CFP · 2212 x 1659 pixels
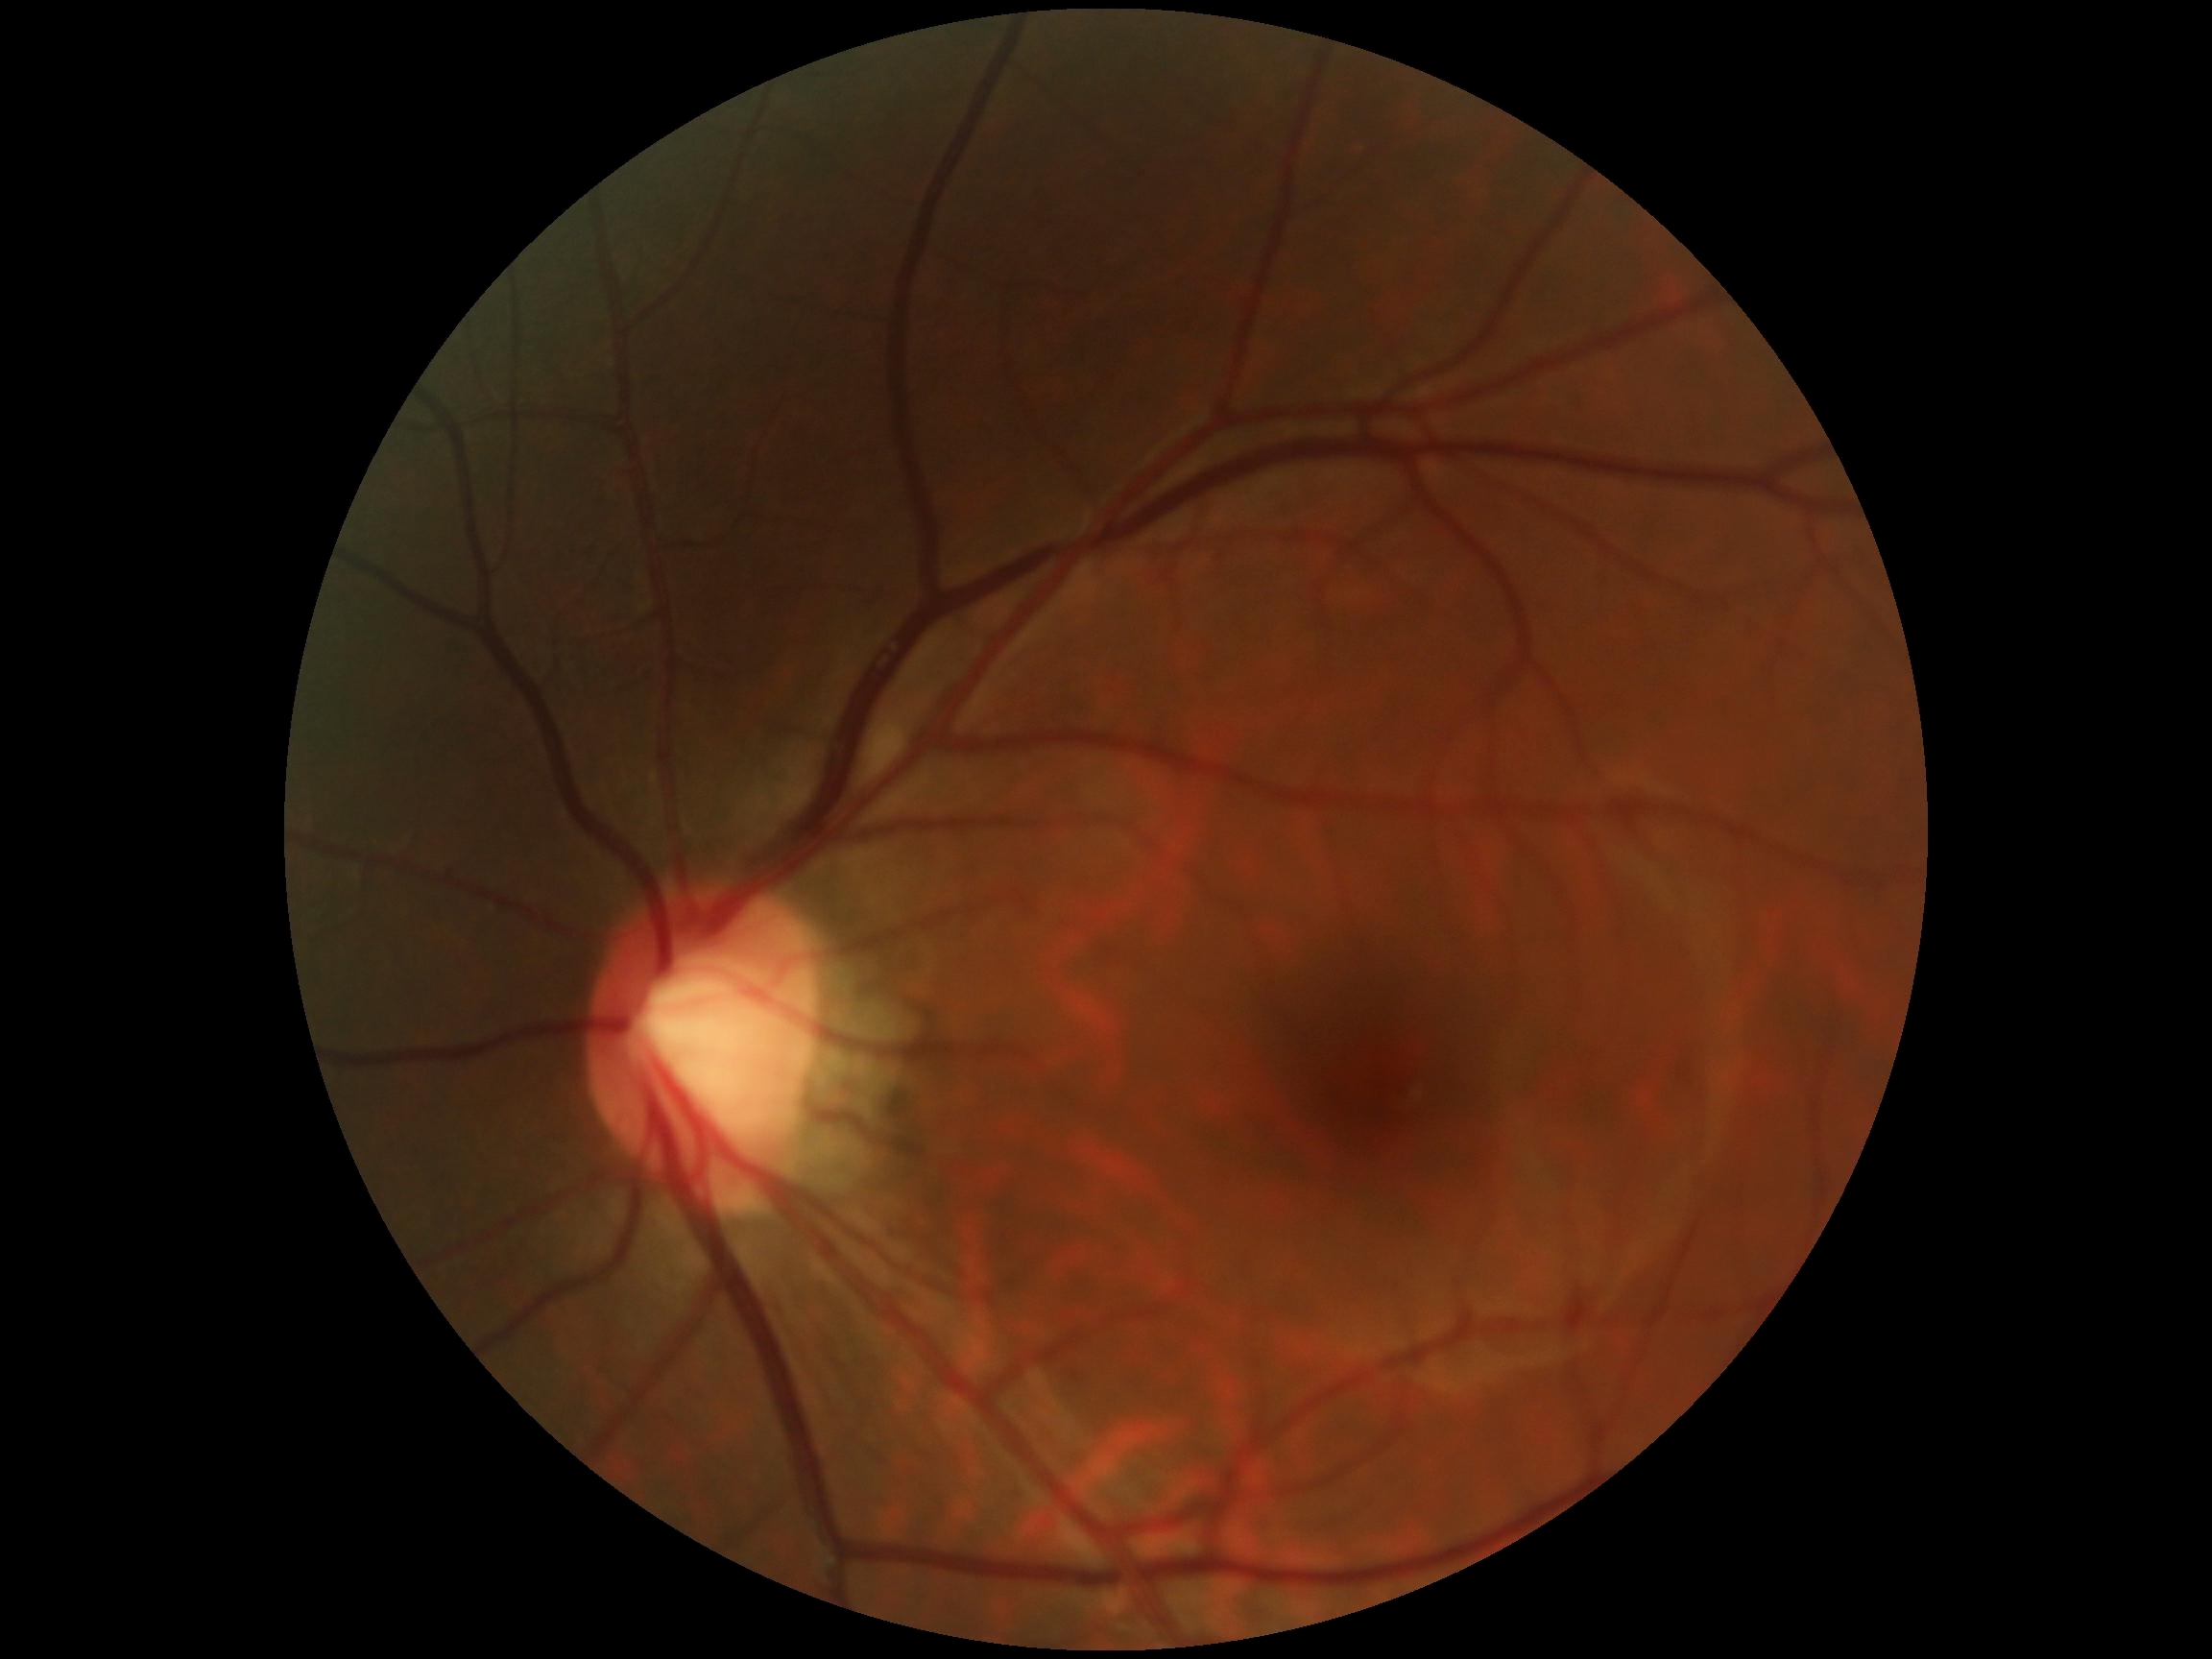 Retinopathy: 0/4.